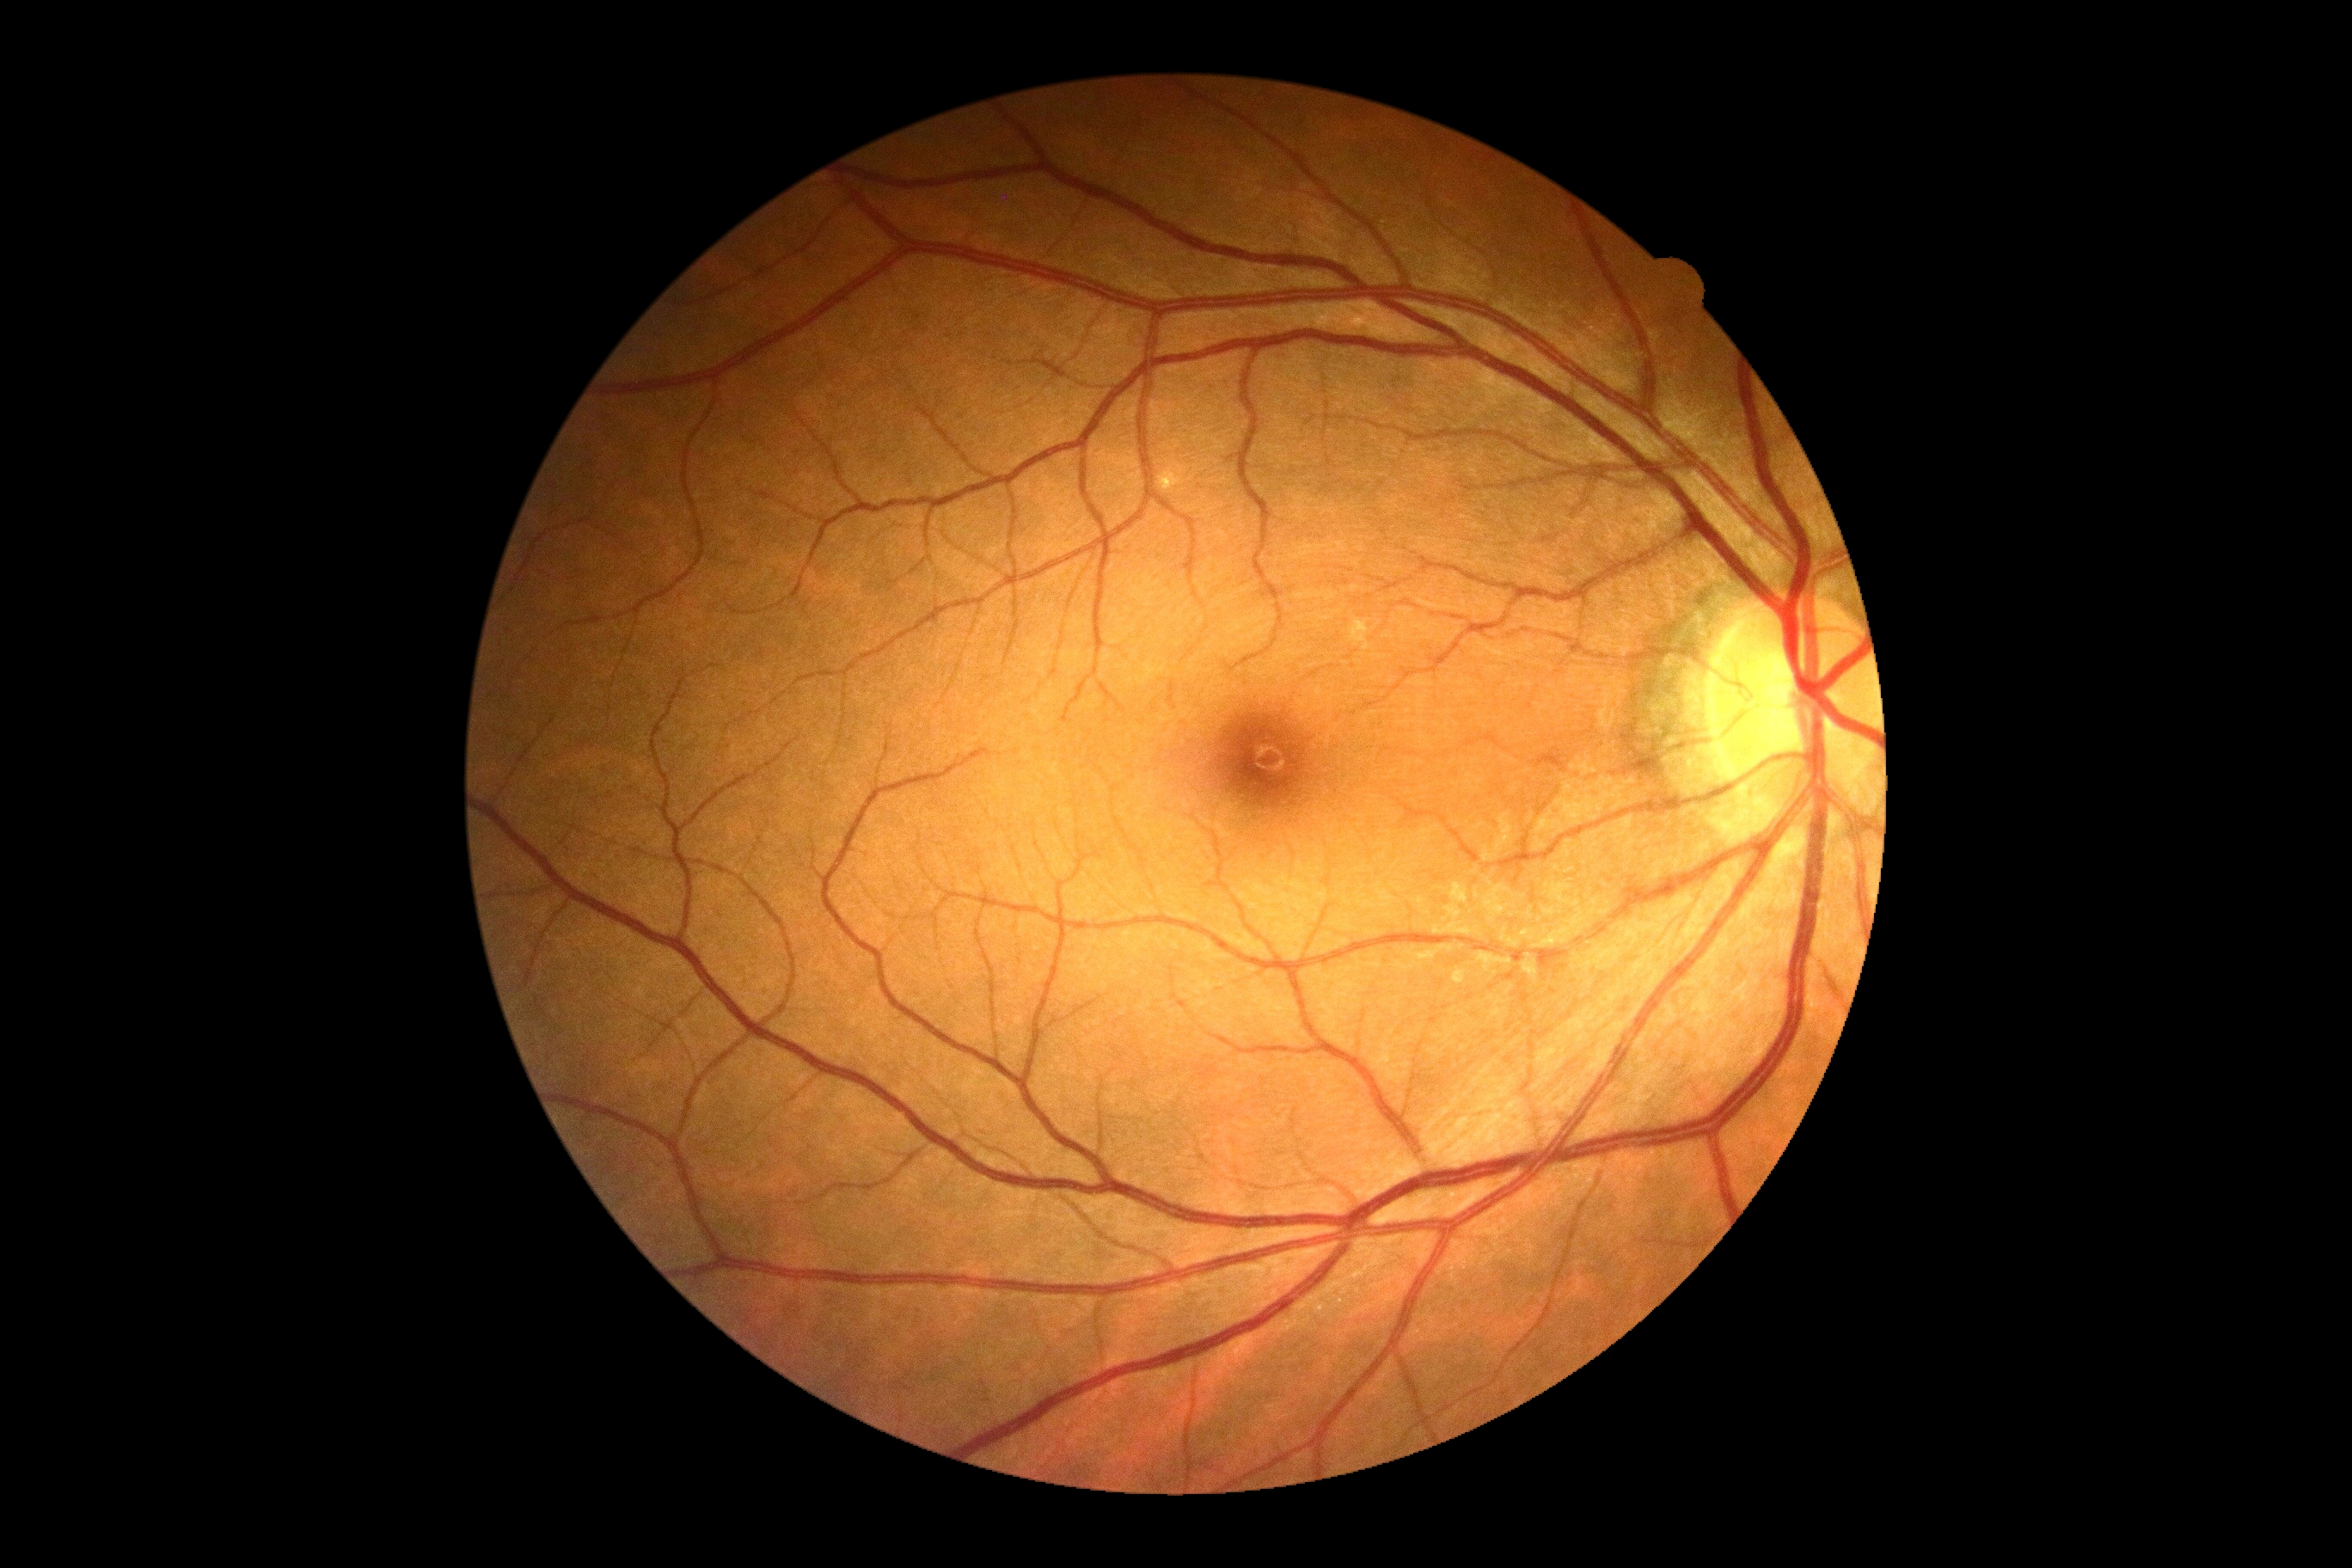 No apparent diabetic retinopathy. Diabetic retinopathy (DR): grade 0 (no apparent retinopathy).